Wide-field fundus image from infant ROP screening. Captured with the Phoenix ICON (100° field of view). 1240x1240px:
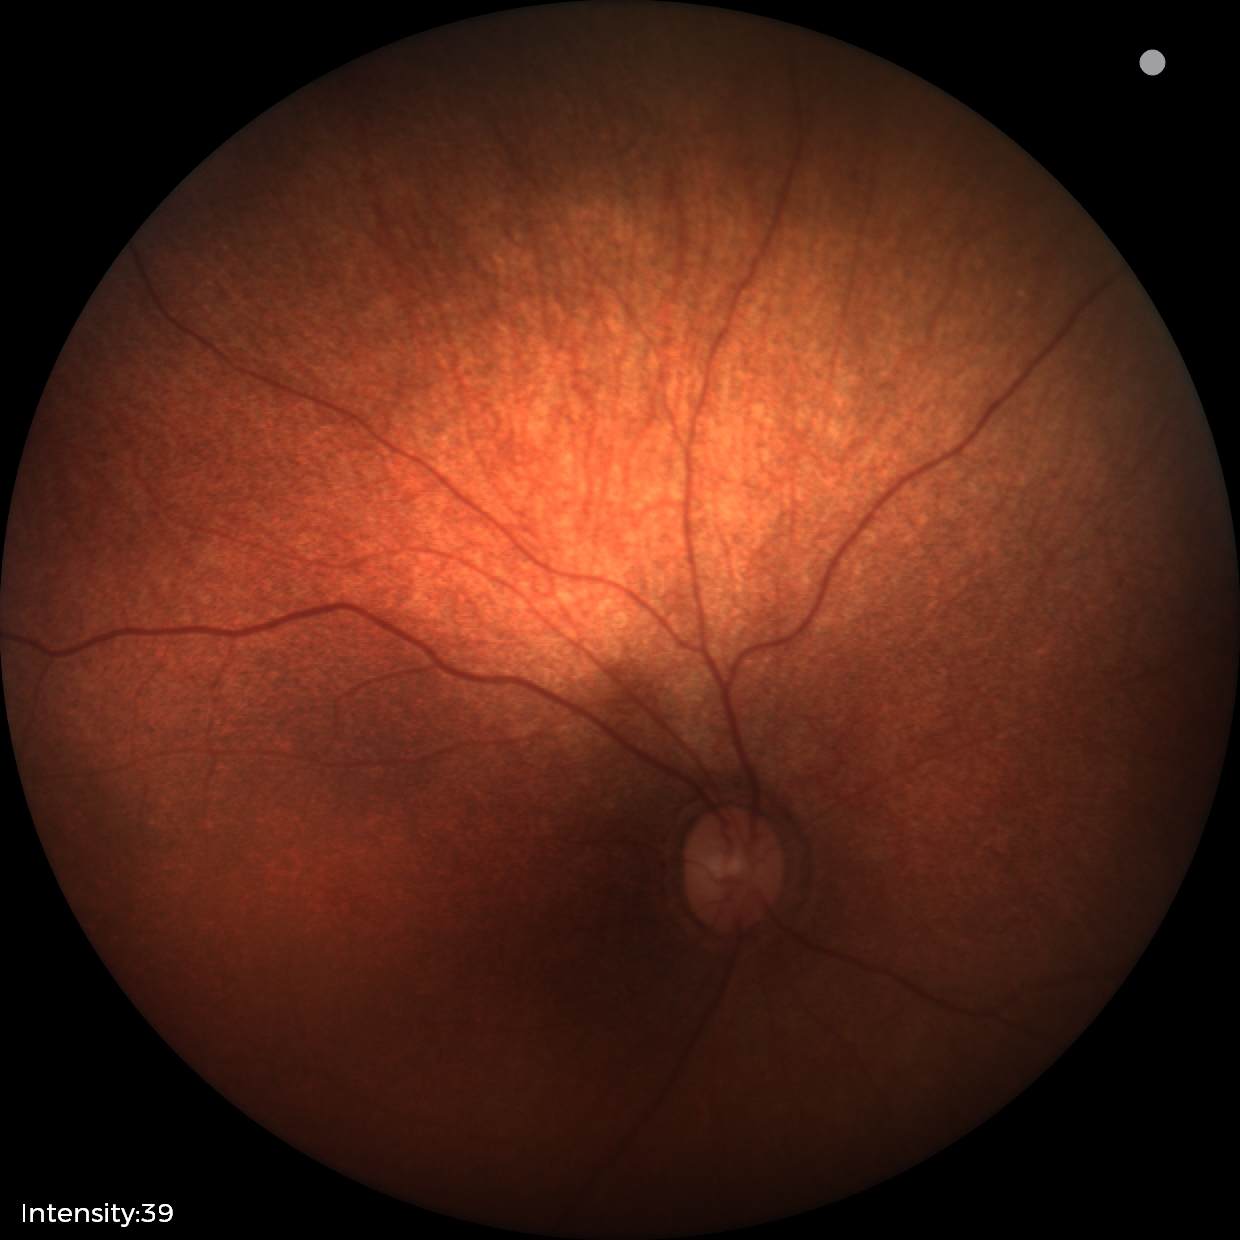 Screening diagnosis: no abnormal retinal findings.